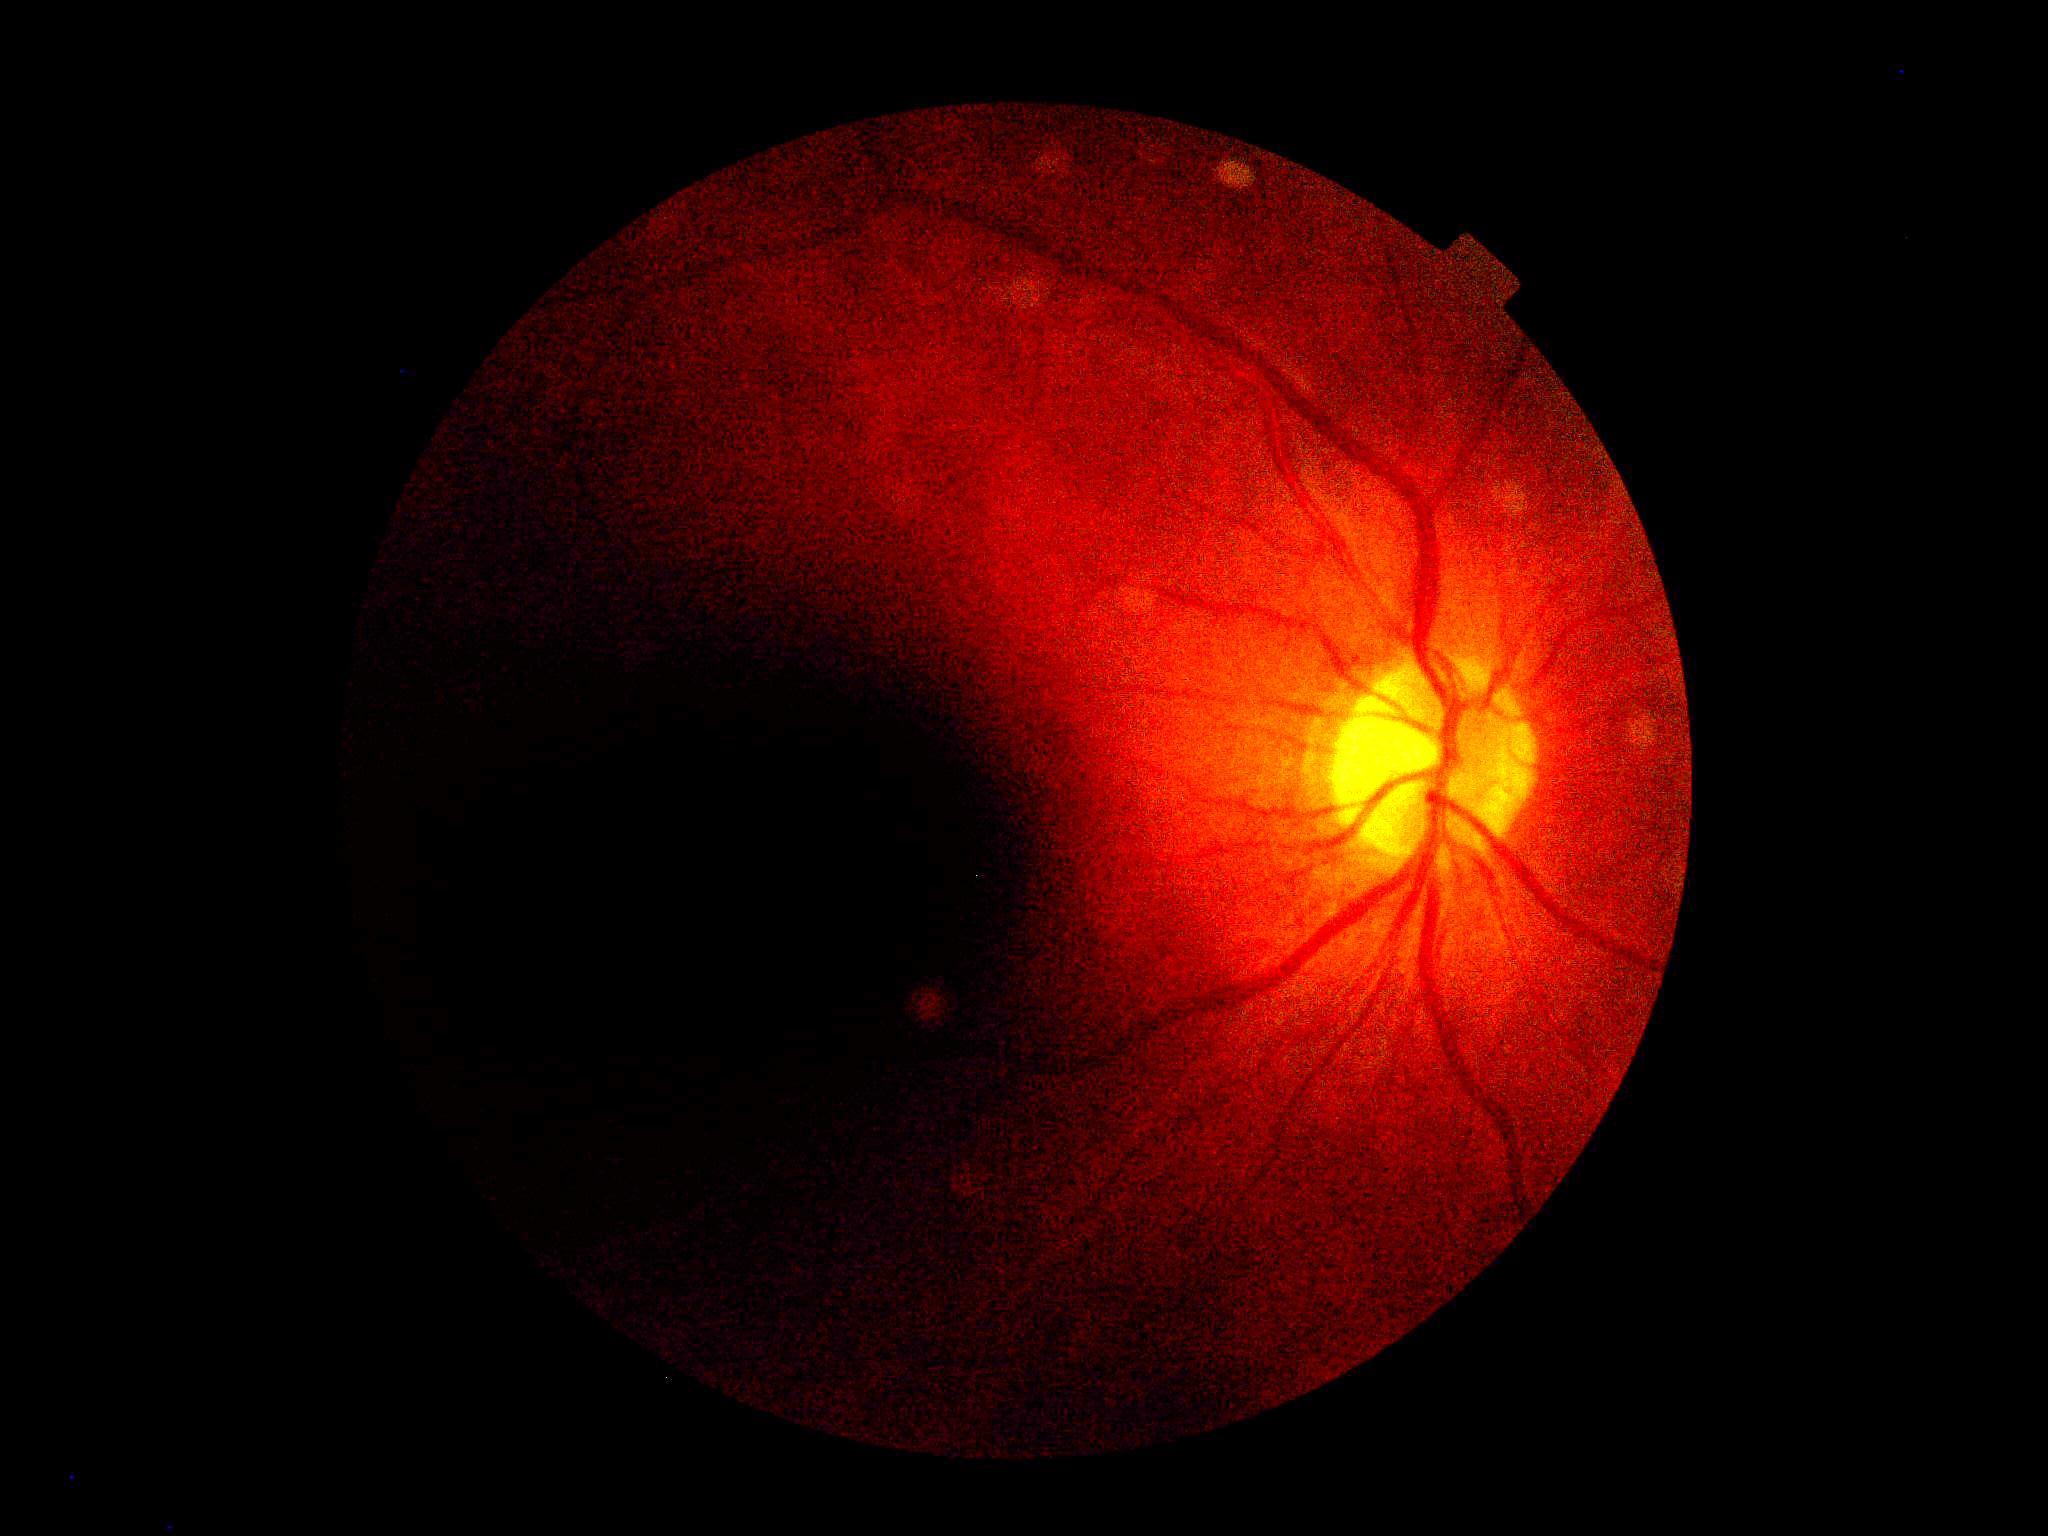
  quality: too poor for DR grading
  dr_grade: ungradable